Wide-field contact fundus photograph of an infant — 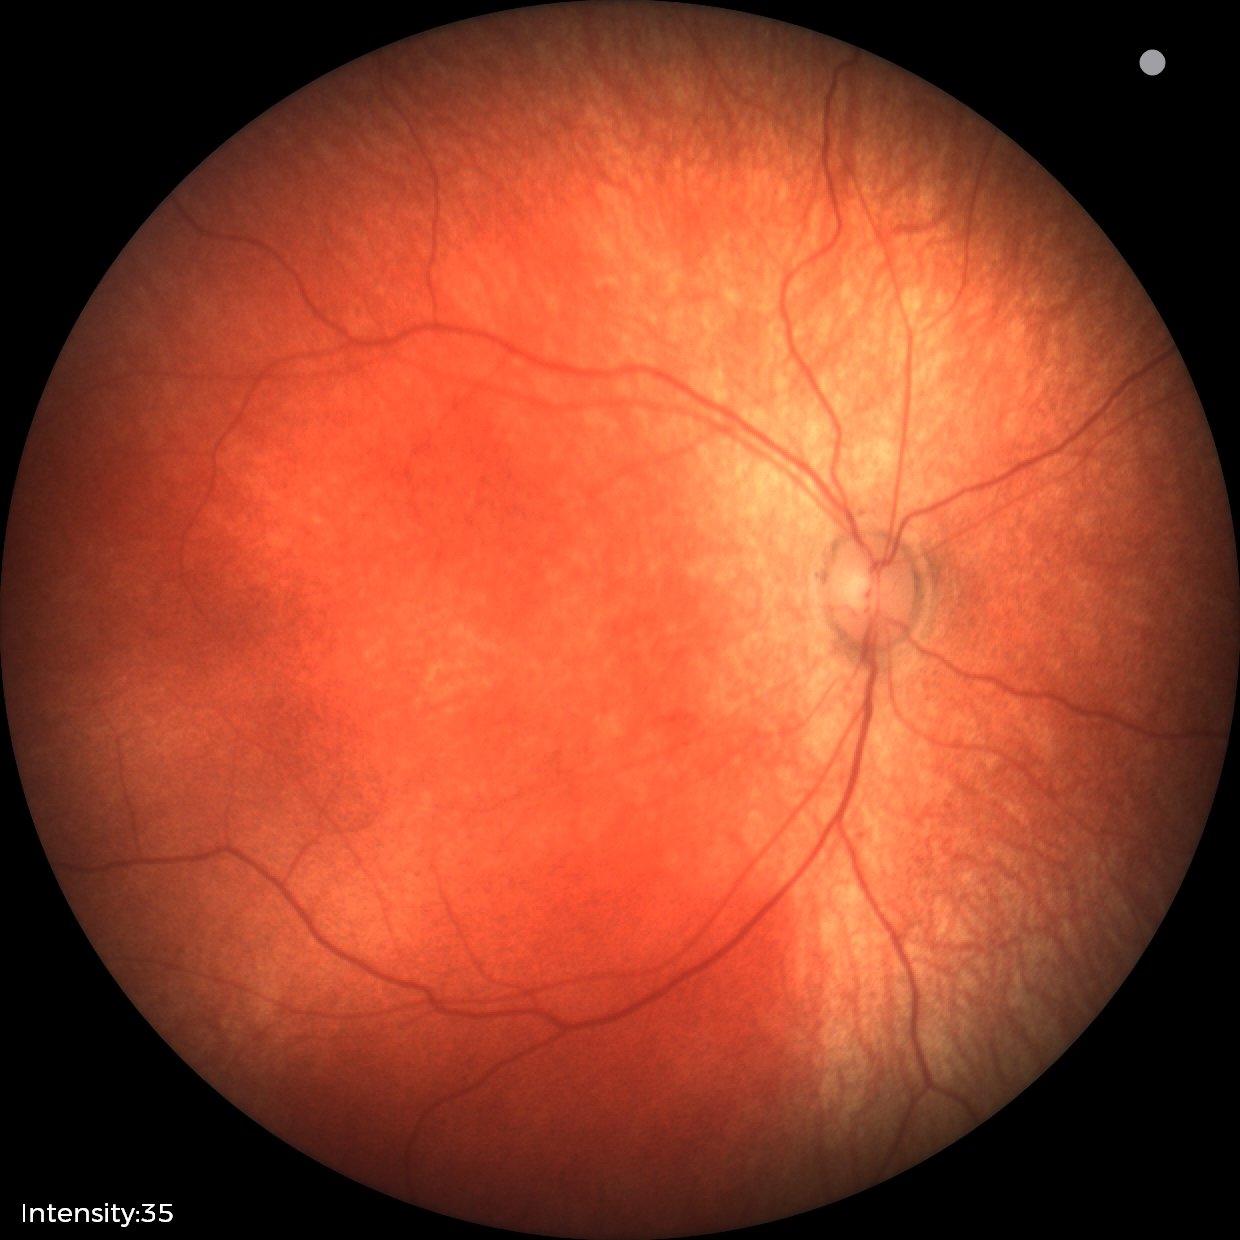
Examination with physiological retinal findings.